Intraocular pressure (IOP) 24 mmHg; non-mydriatic; 30° FOV
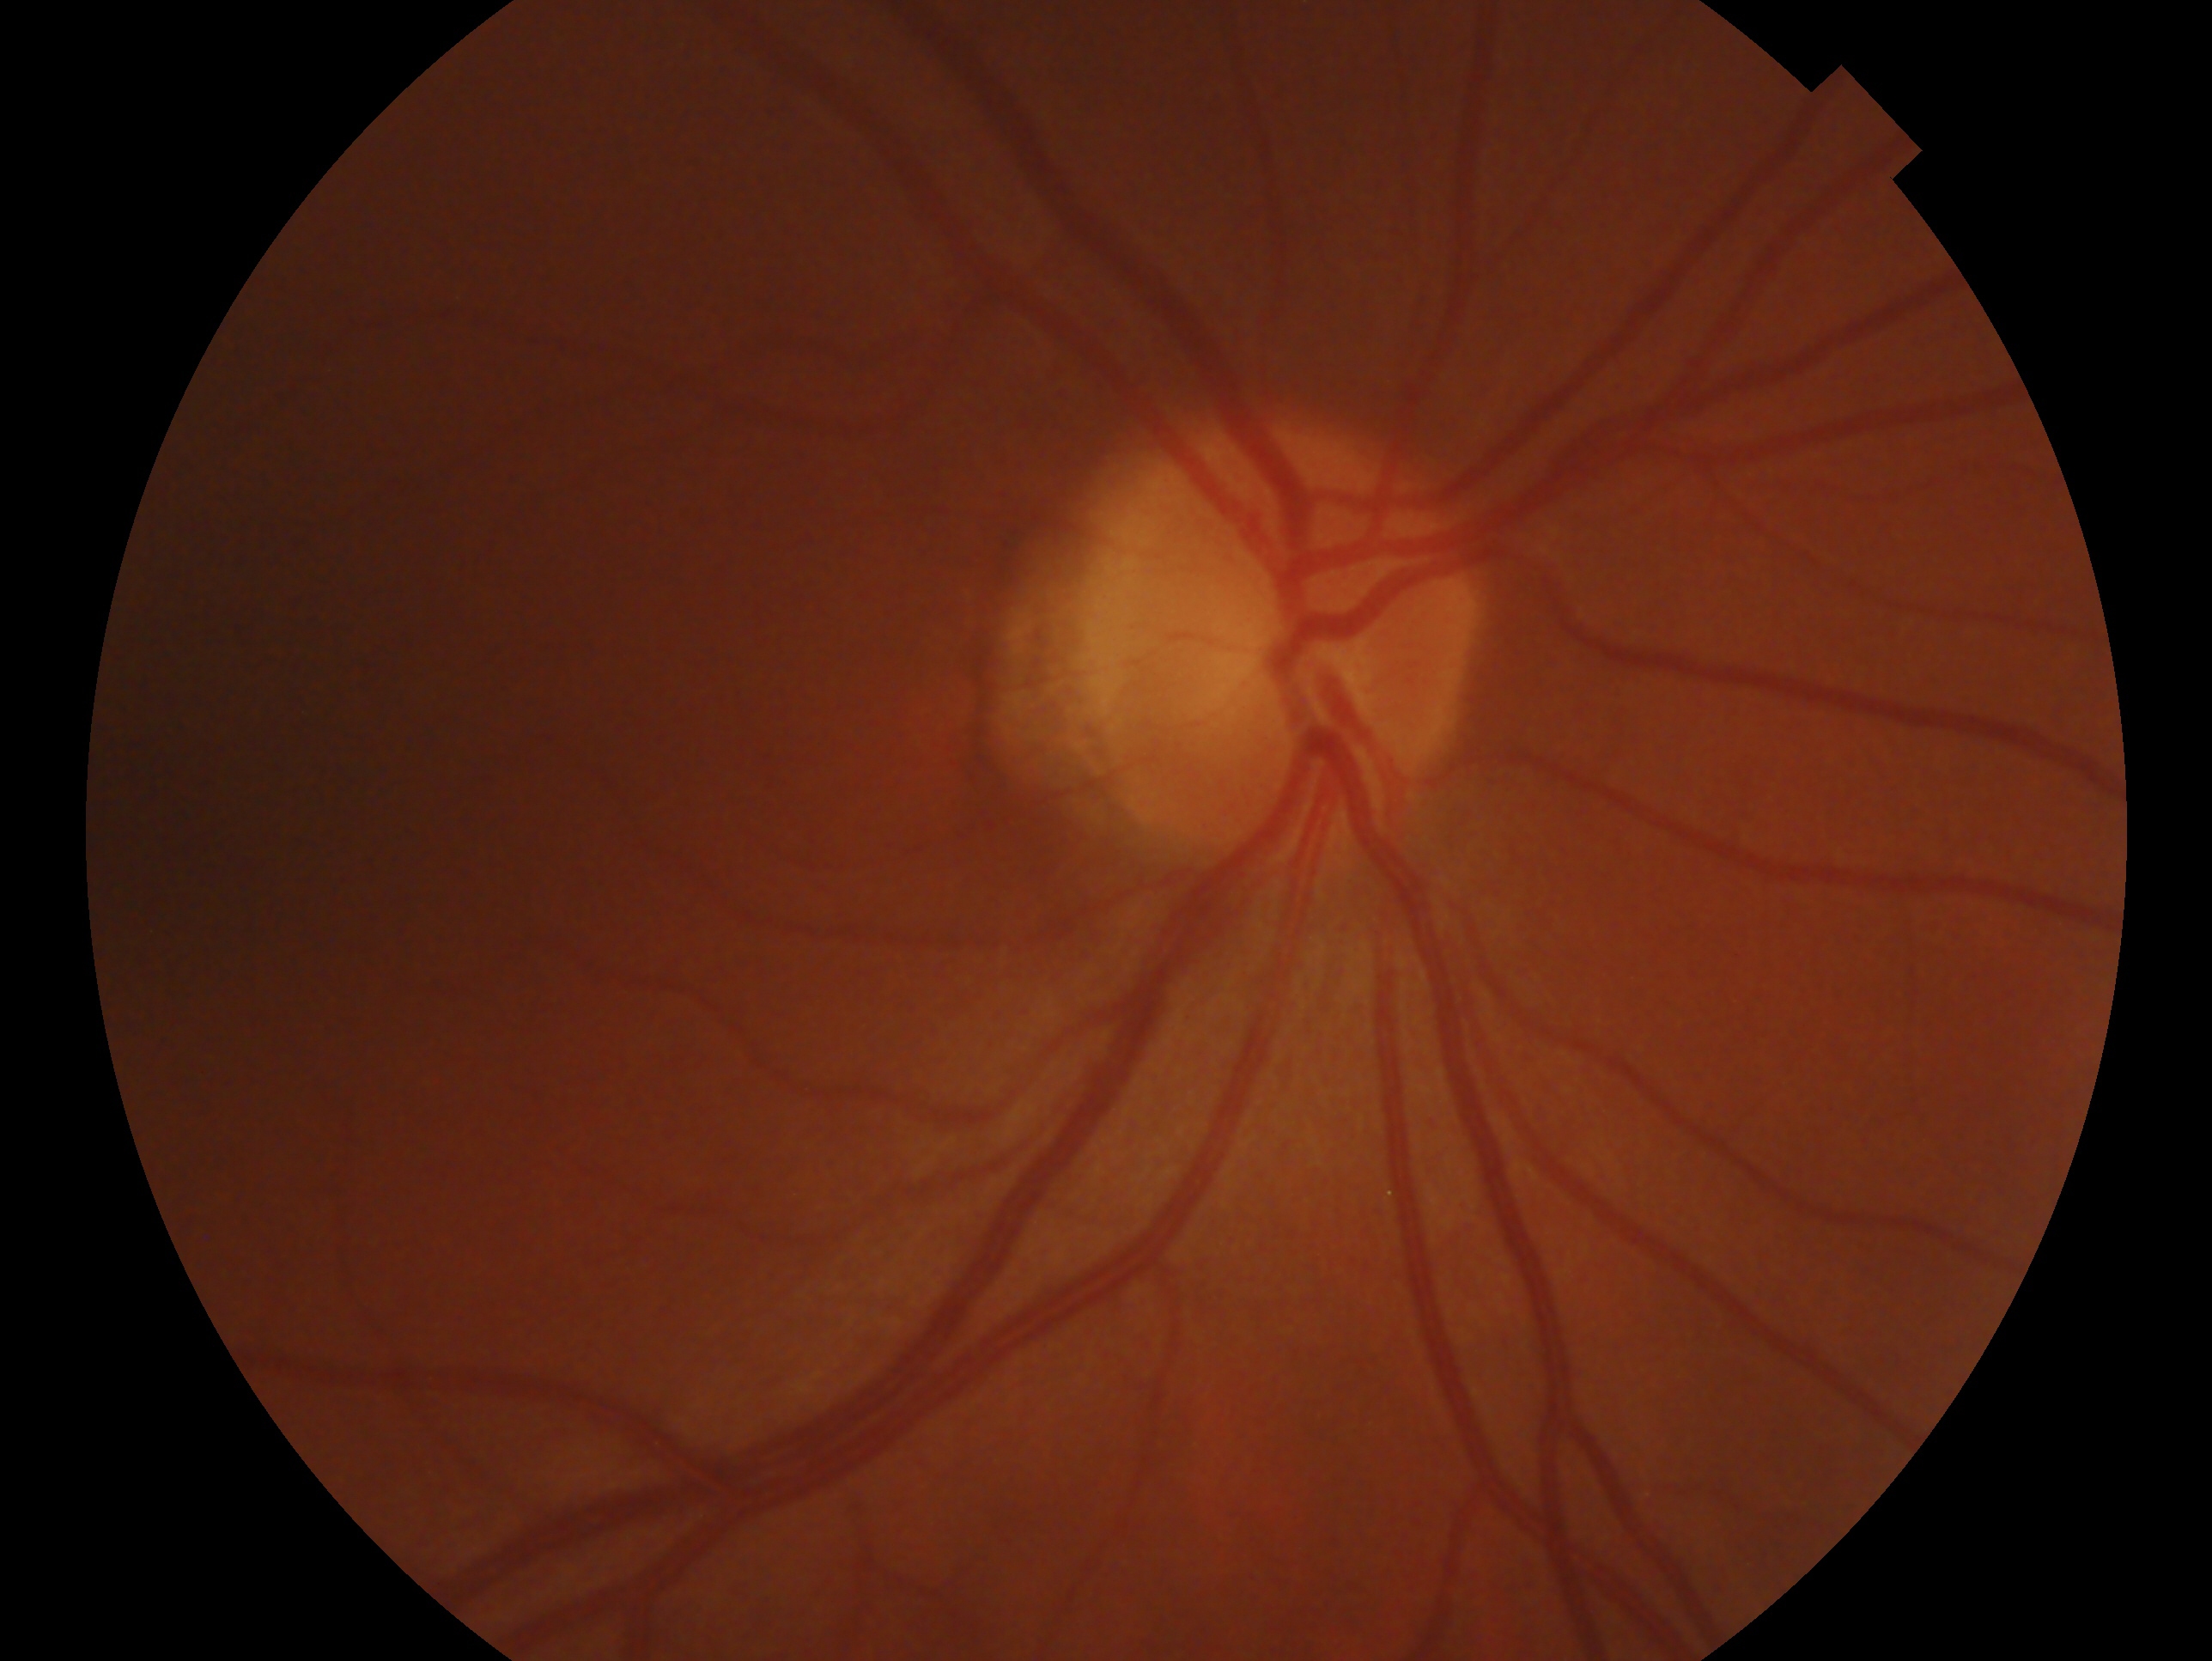 This is the OD.
Assessment: negative for glaucoma.